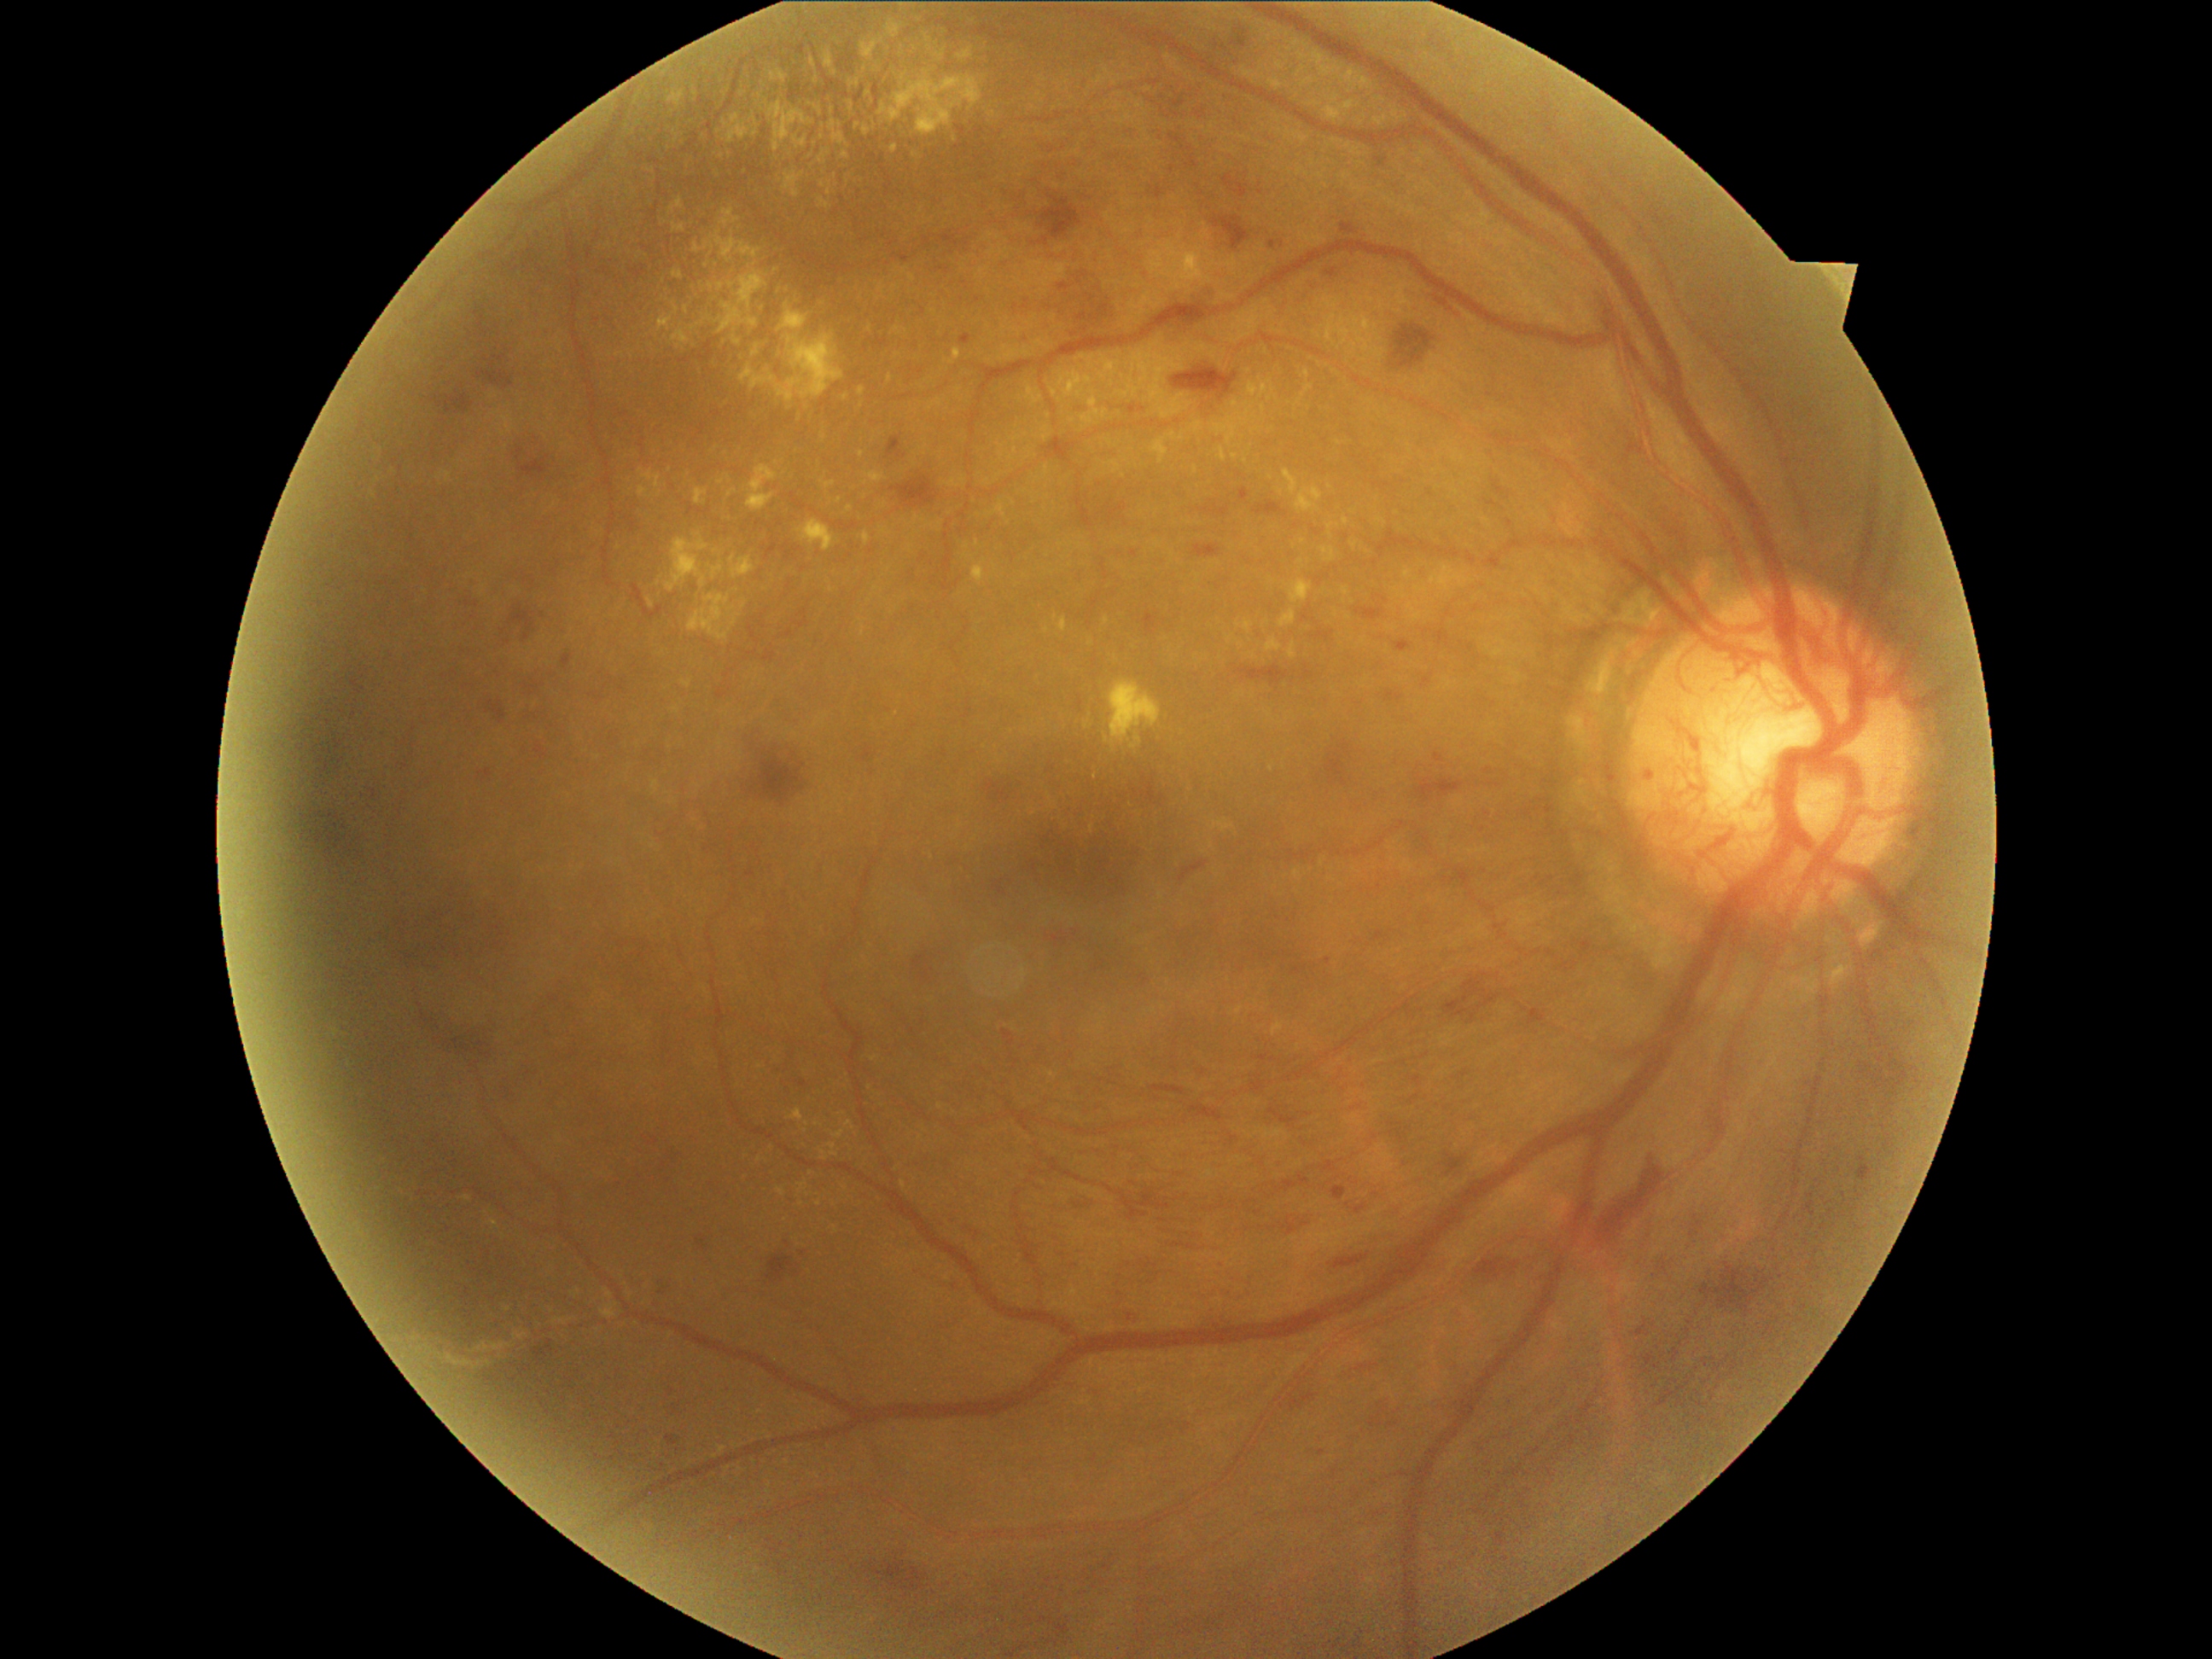
Diabetic retinopathy (DR) is grade 4
Lesions identified (partial list):
hard exudates (EXs) (partial): box=[492, 1342, 508, 1353]; box=[733, 337, 742, 346]; box=[731, 59, 764, 112]; box=[1322, 547, 1336, 562]; box=[1278, 62, 1284, 71]; box=[818, 153, 829, 165]; box=[714, 537, 735, 552]; box=[800, 1182, 808, 1192]; box=[709, 282, 714, 291]; box=[1249, 380, 1271, 399]; box=[1238, 410, 1252, 428]; box=[1296, 67, 1307, 78]; box=[1312, 52, 1337, 78]; box=[574, 1289, 581, 1298]
Smaller EXs around 838:501; 822:138; 618:547; 823:438; 1245:461; 627:1286